Color fundus photograph; image size 2089x1764:
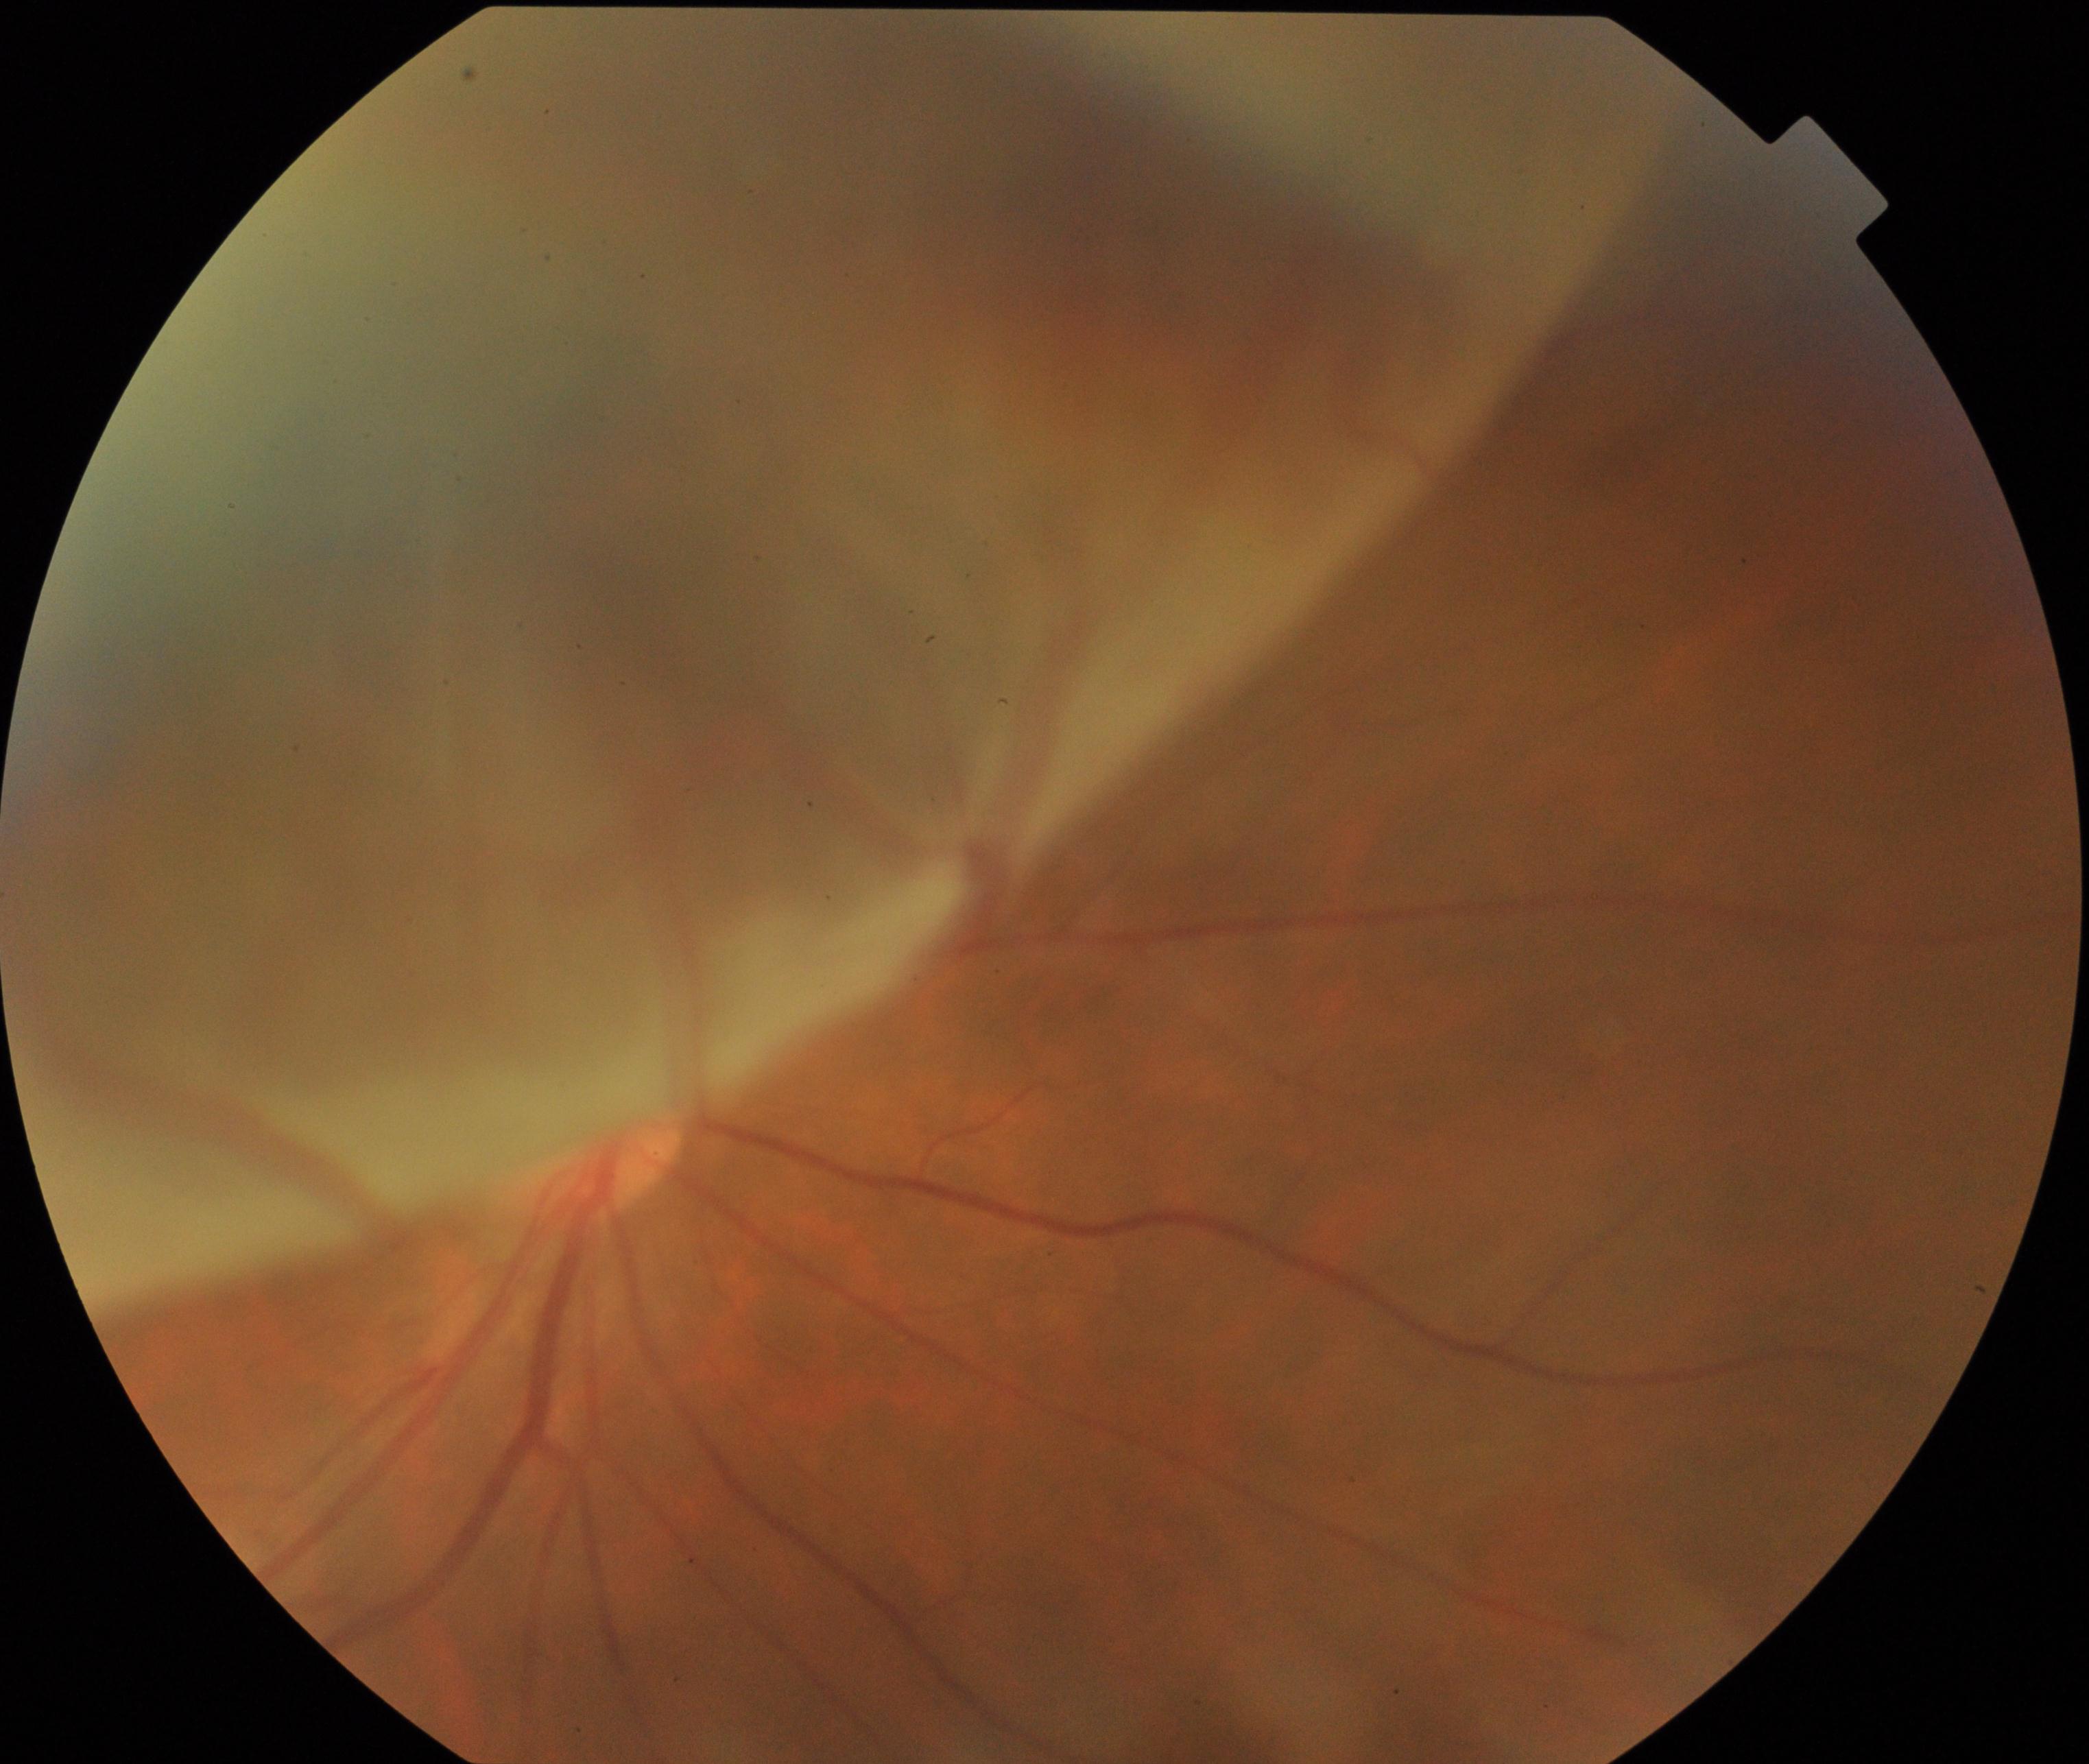

Impression: rhegmatogenous retinal detachment.